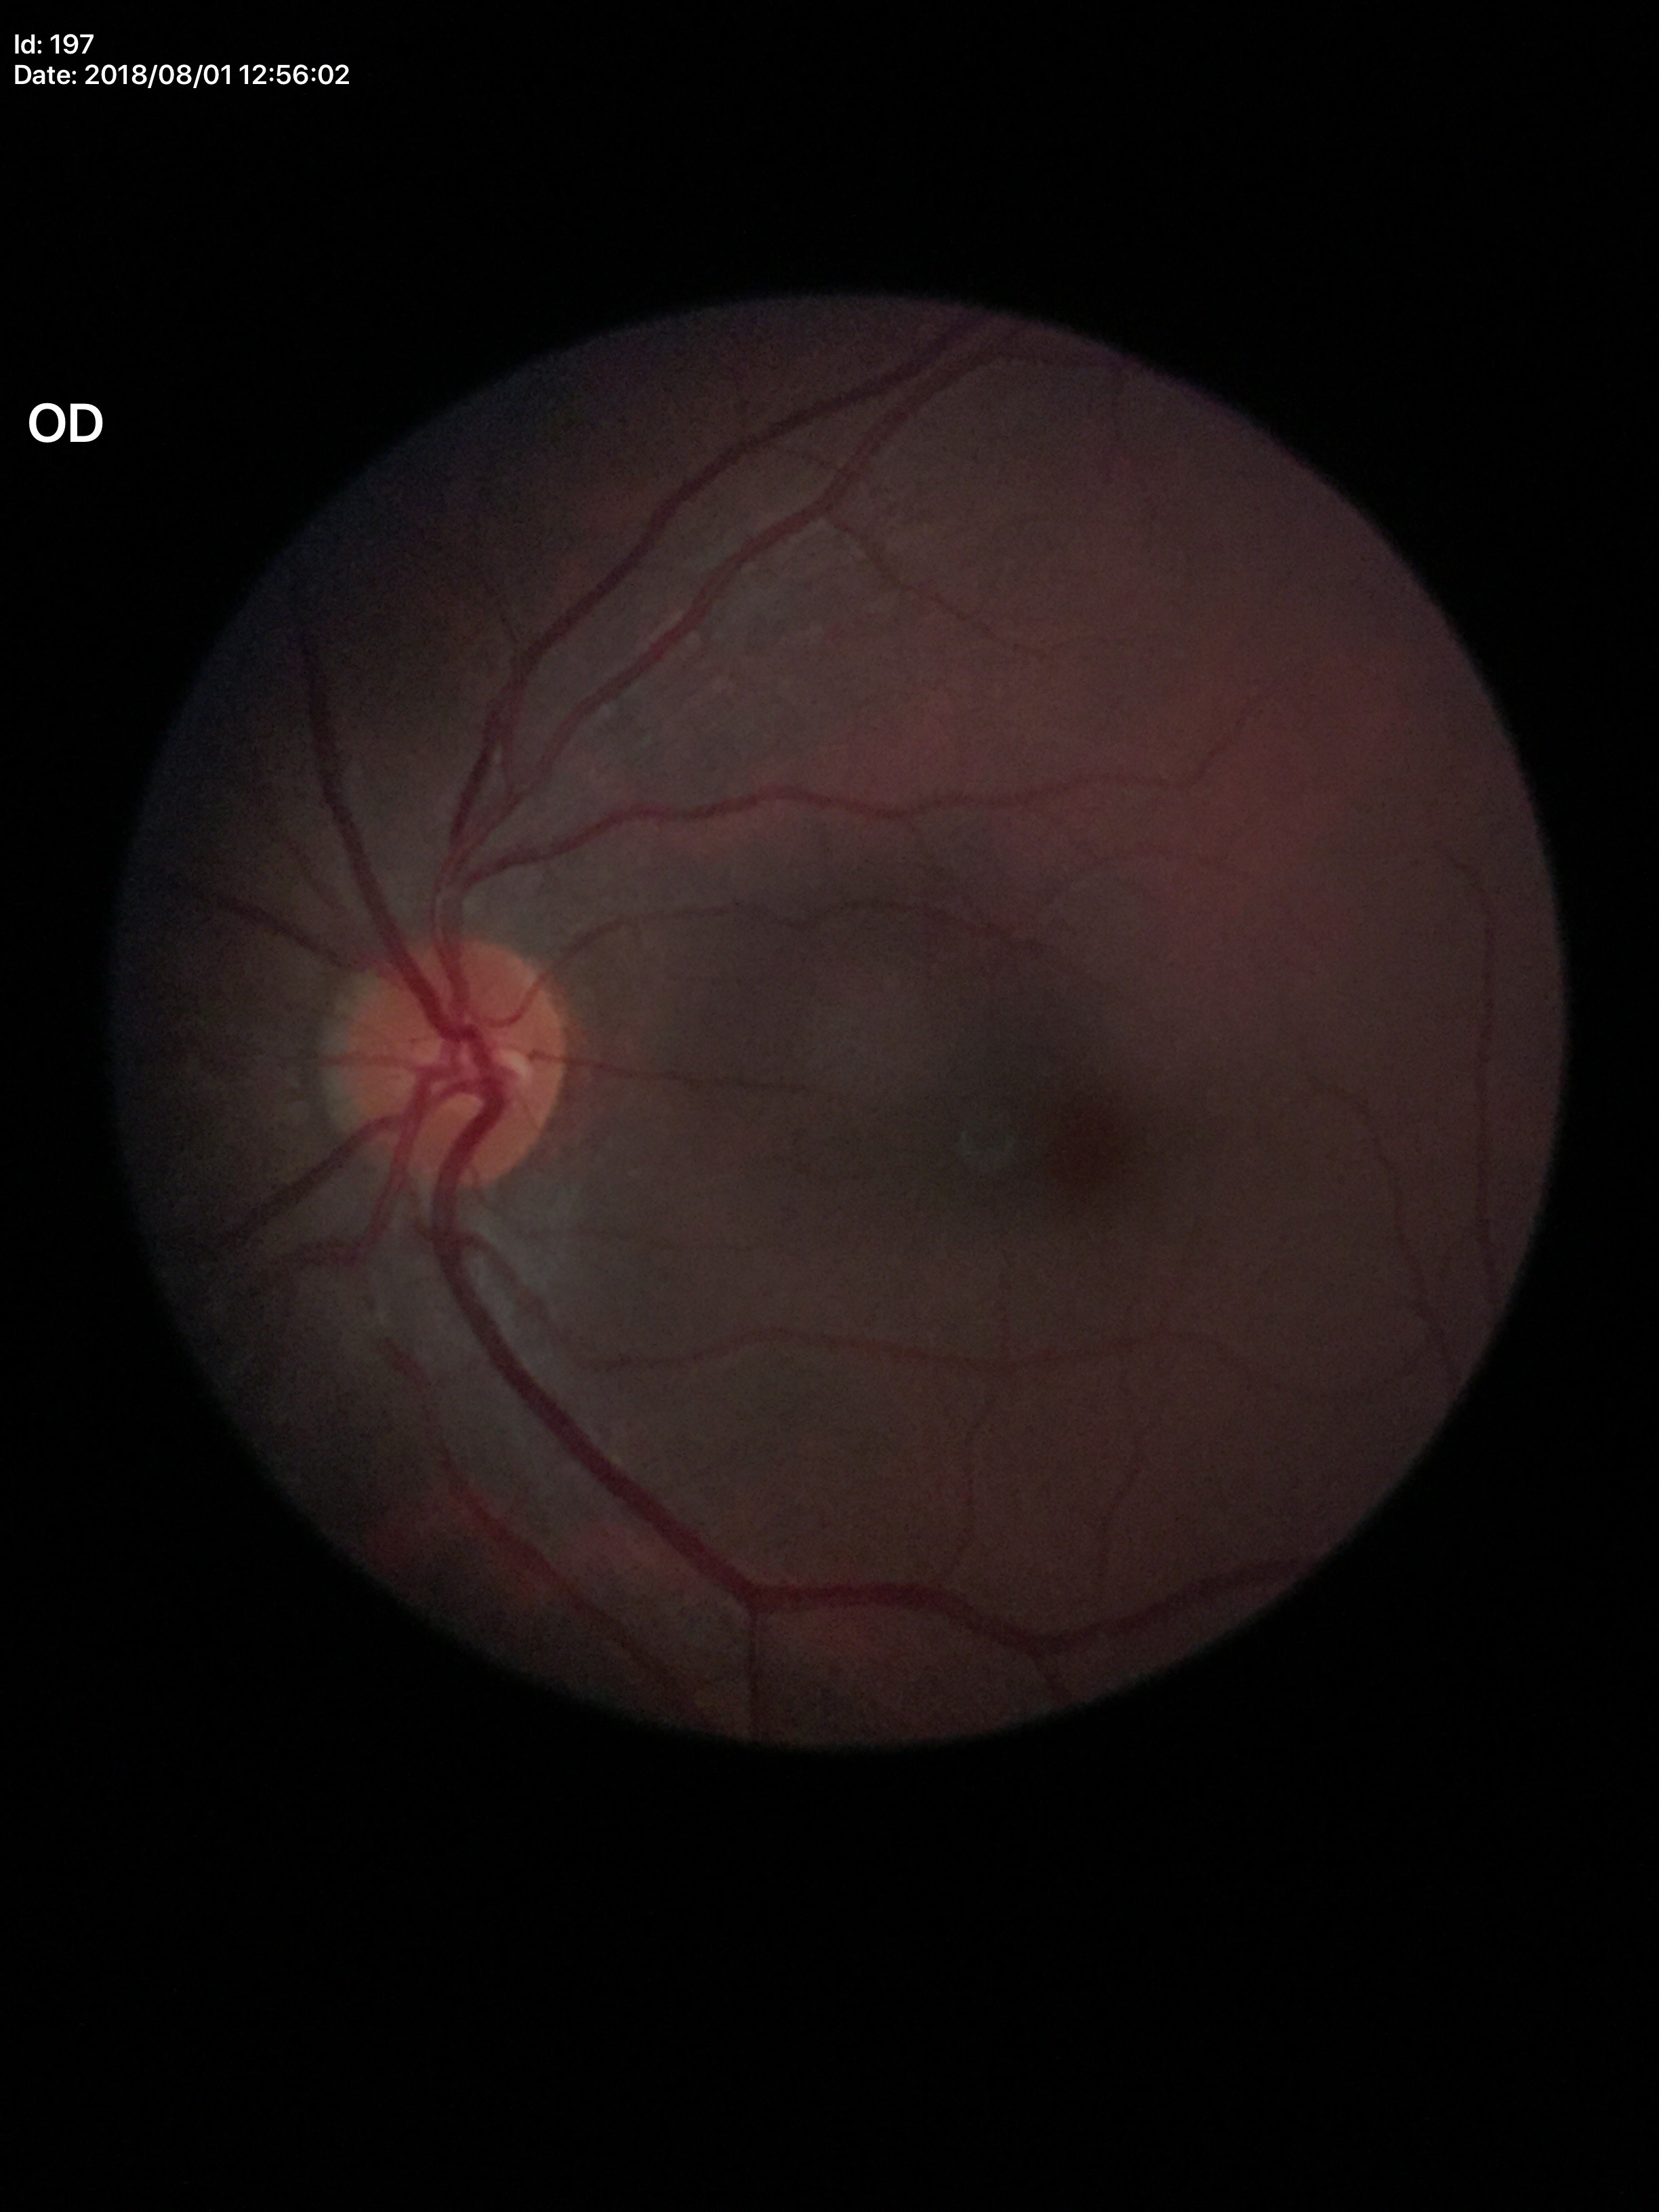

Glaucoma screening impression: negative
vertical CDR: 0.45